Infant wide-field retinal image — 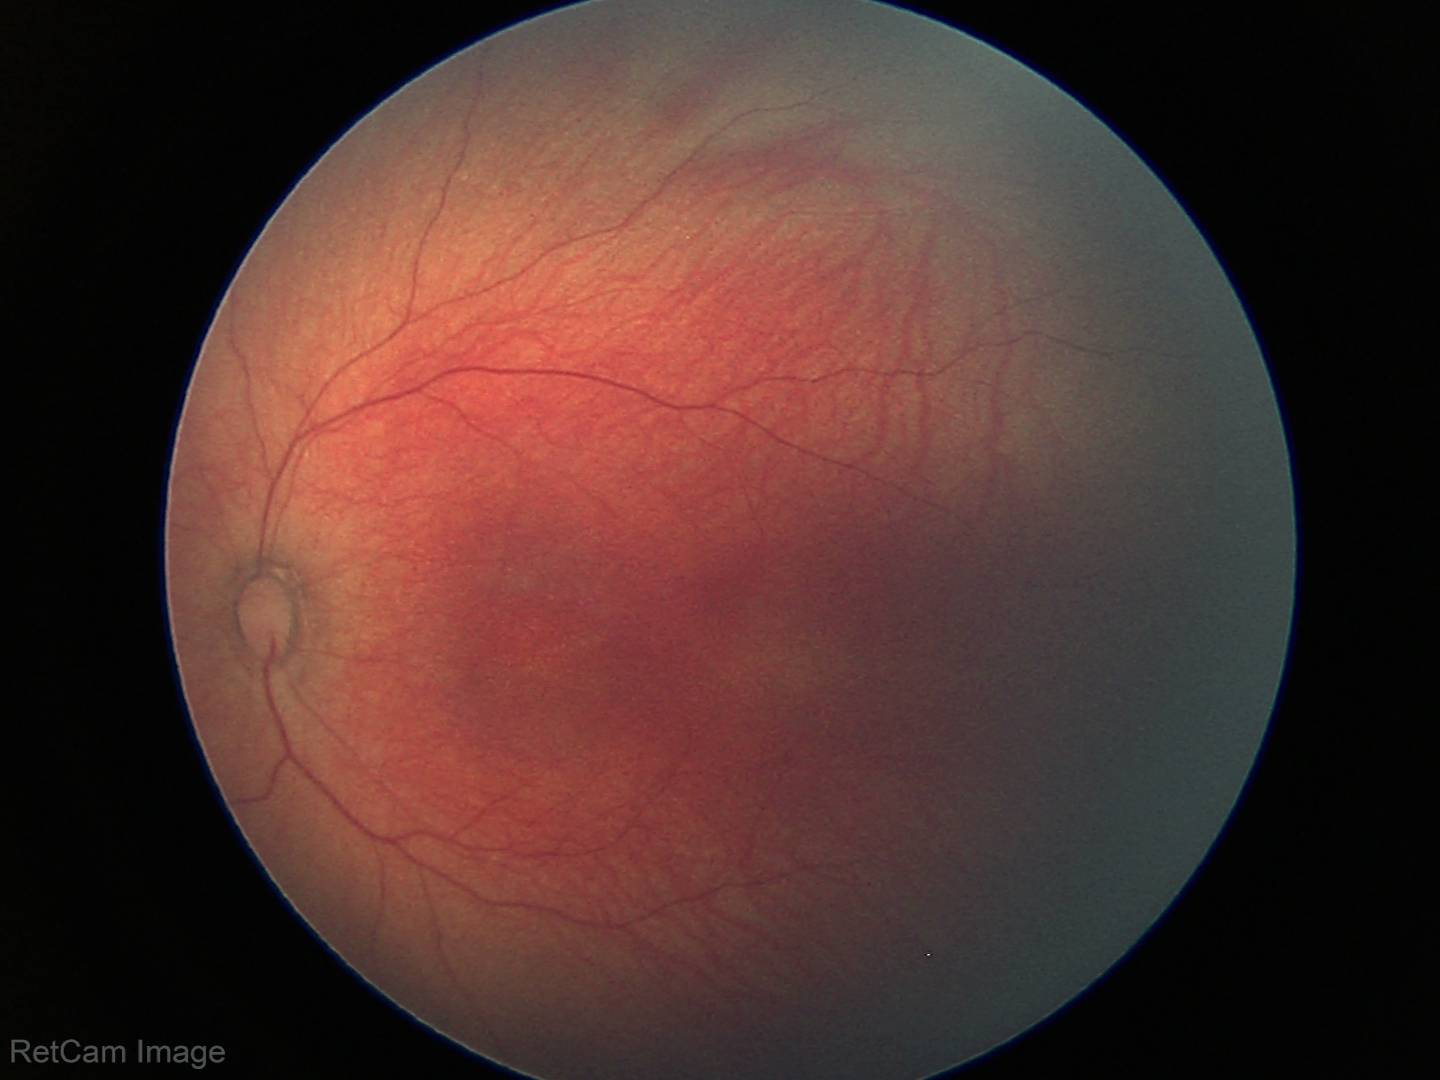
Q: What is the diagnosis from this examination?
A: no abnormal retinal findings